640x480px · wide-field fundus photograph of an infant · camera: Clarity RetCam 3 (130° FOV):
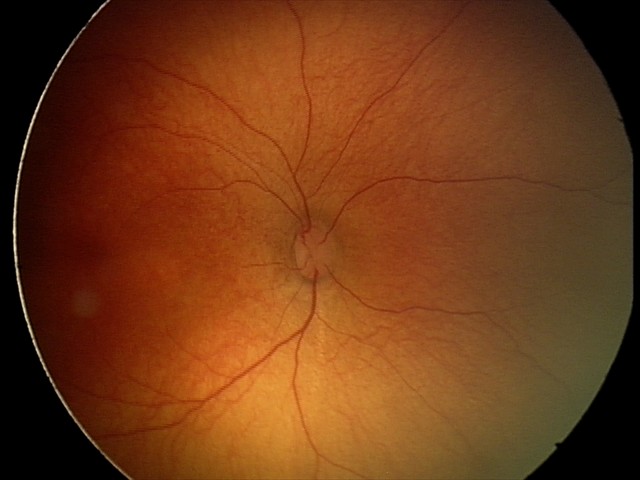
Screening diagnosis = normal retinal appearance